1932 by 1916 pixels.
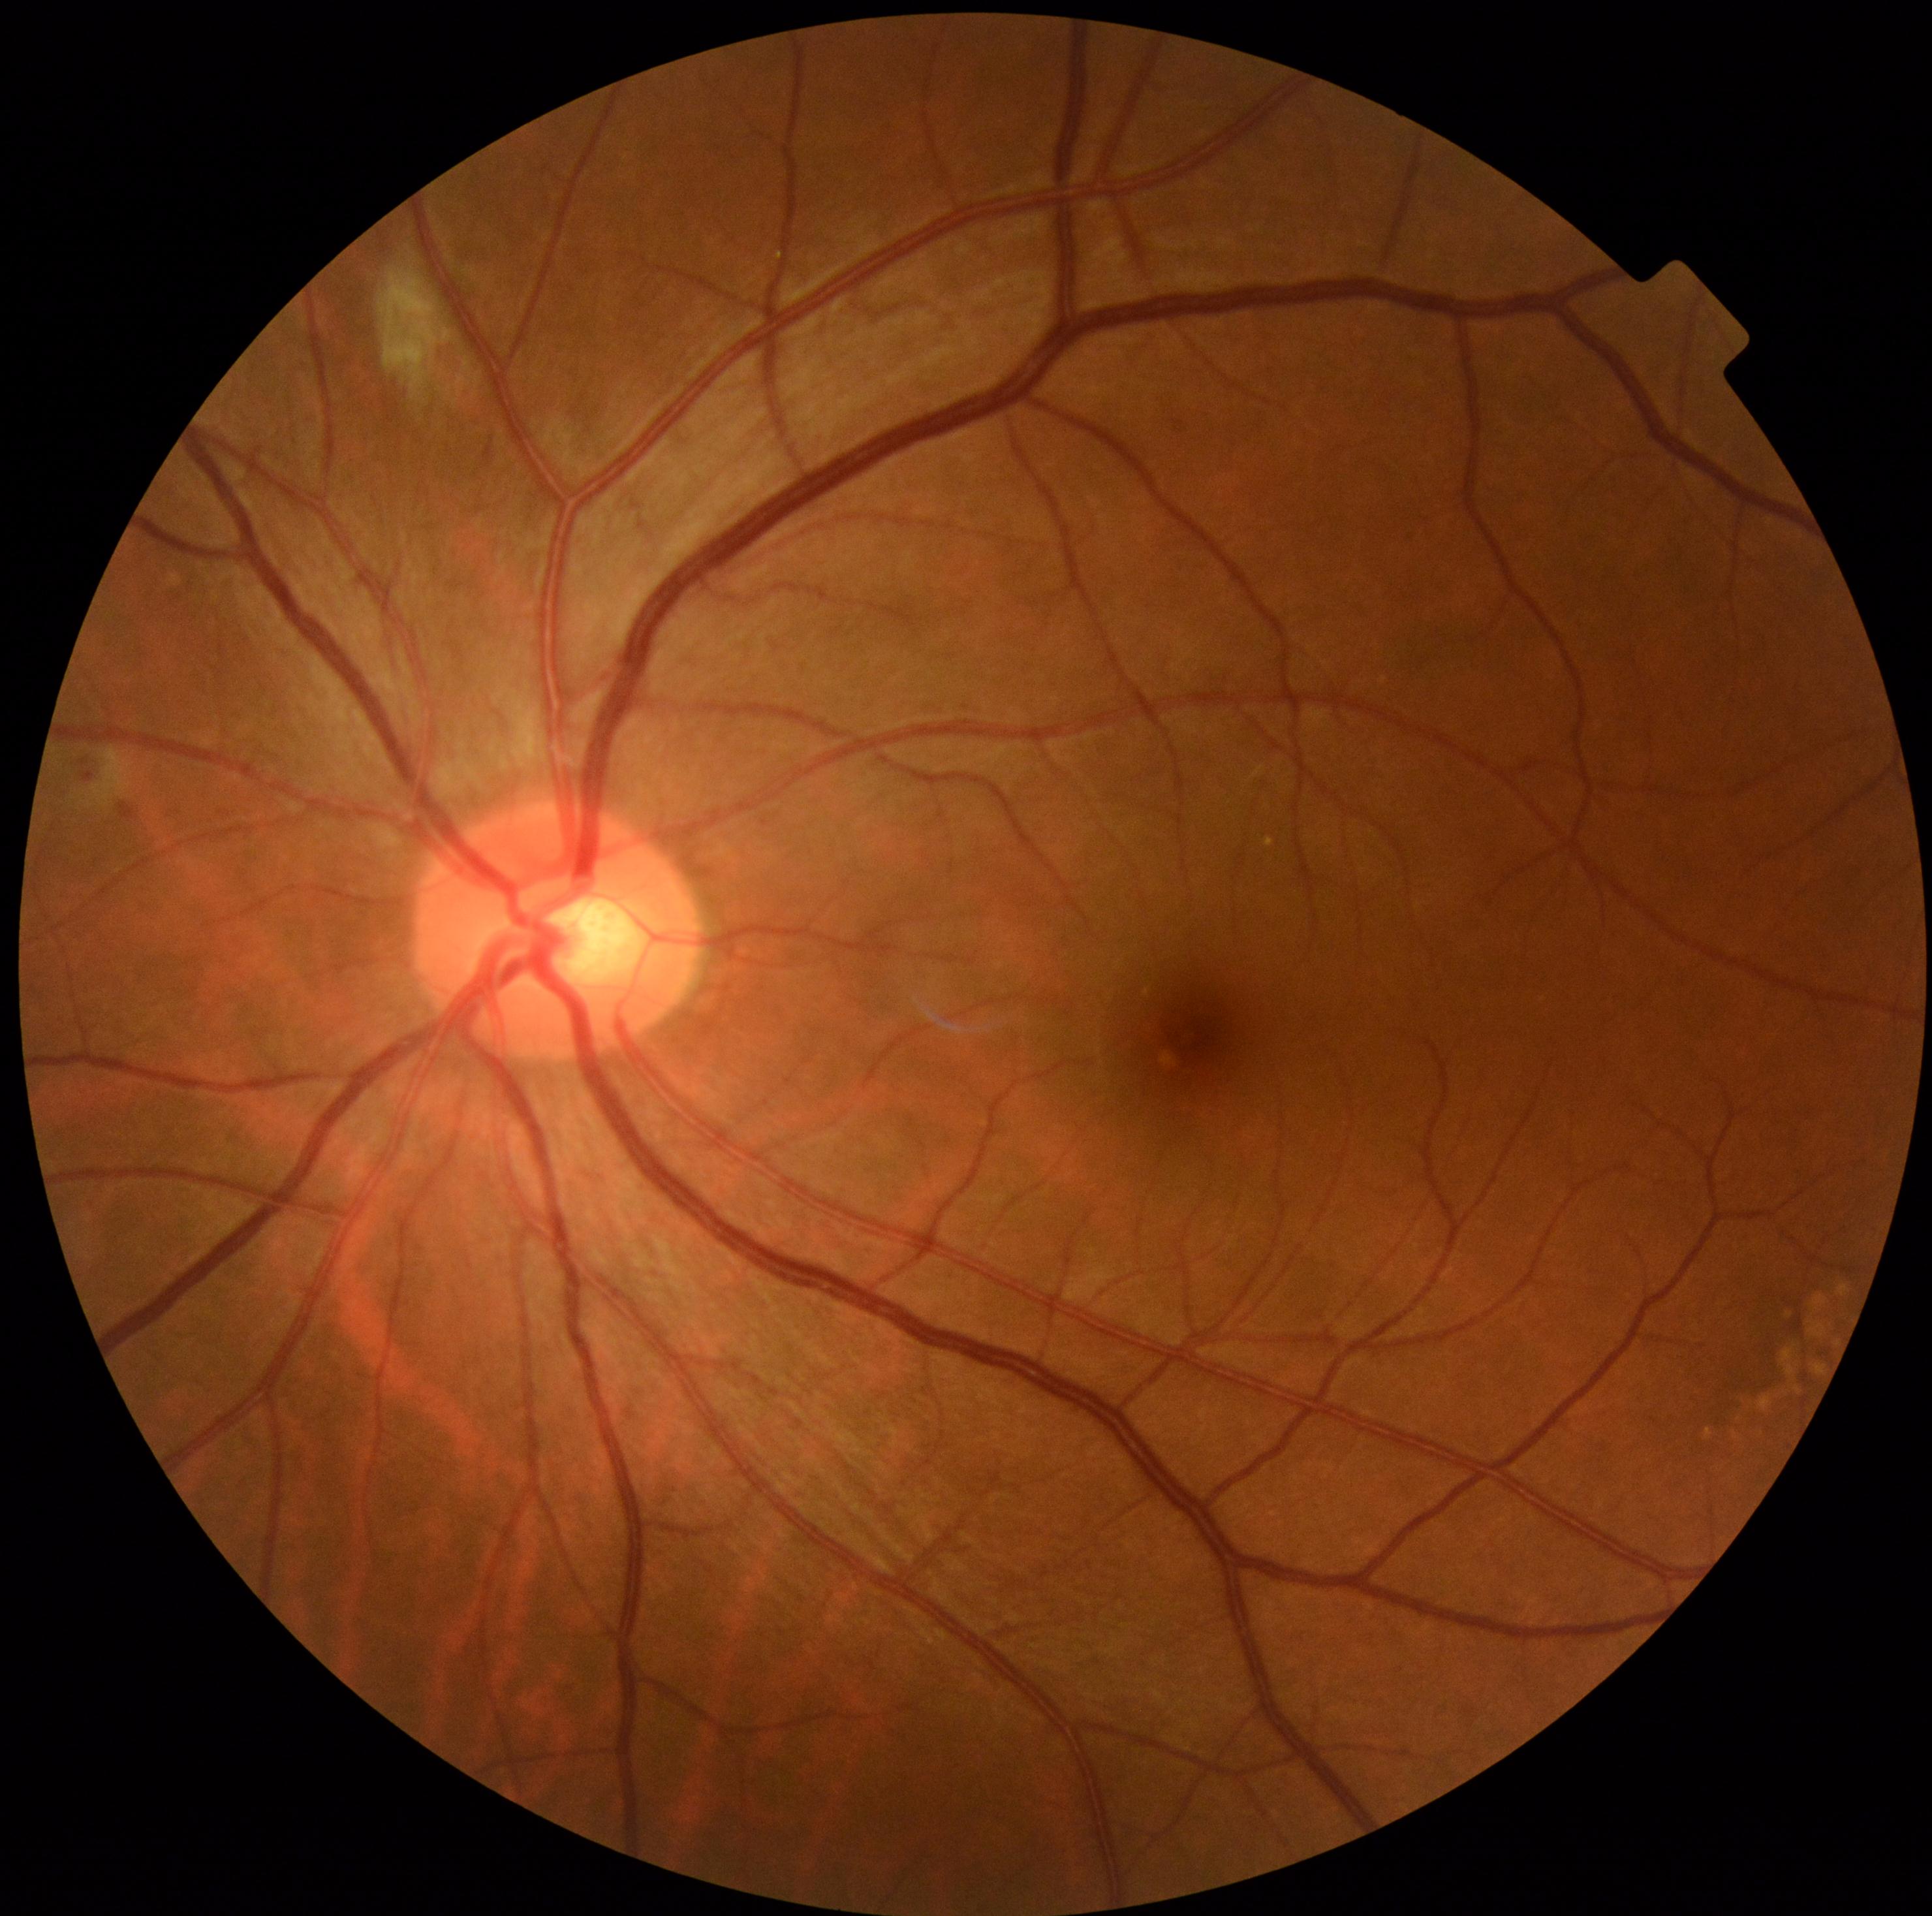 DR: moderate NPDR (grade 2).